Pediatric retinal photograph (wide-field):
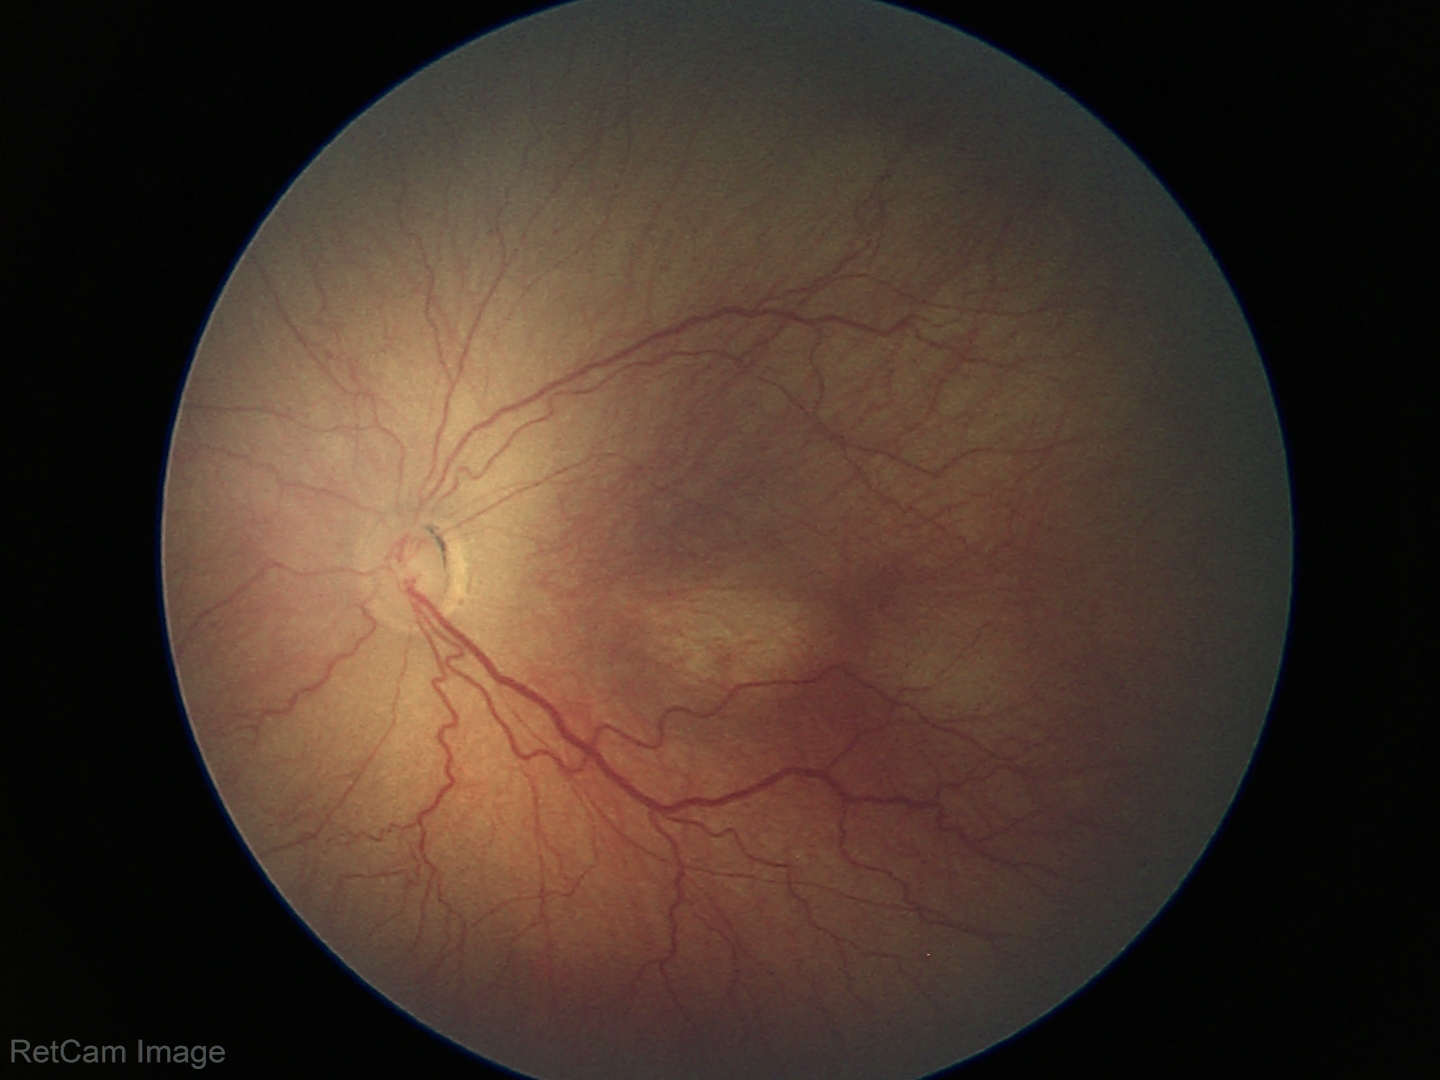

Series diagnosed as ROP stage 3. No plus disease.